Tabletop color fundus camera image:
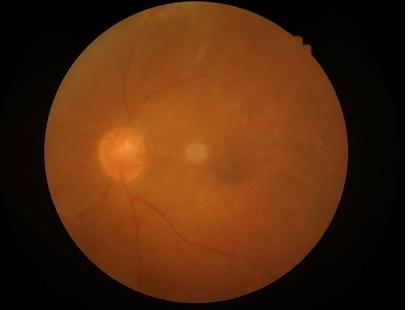 Reduced sharpness with visible blur. Narrow intensity range; structures are hard to distinguish. Image quality is inadequate for diagnostic use.